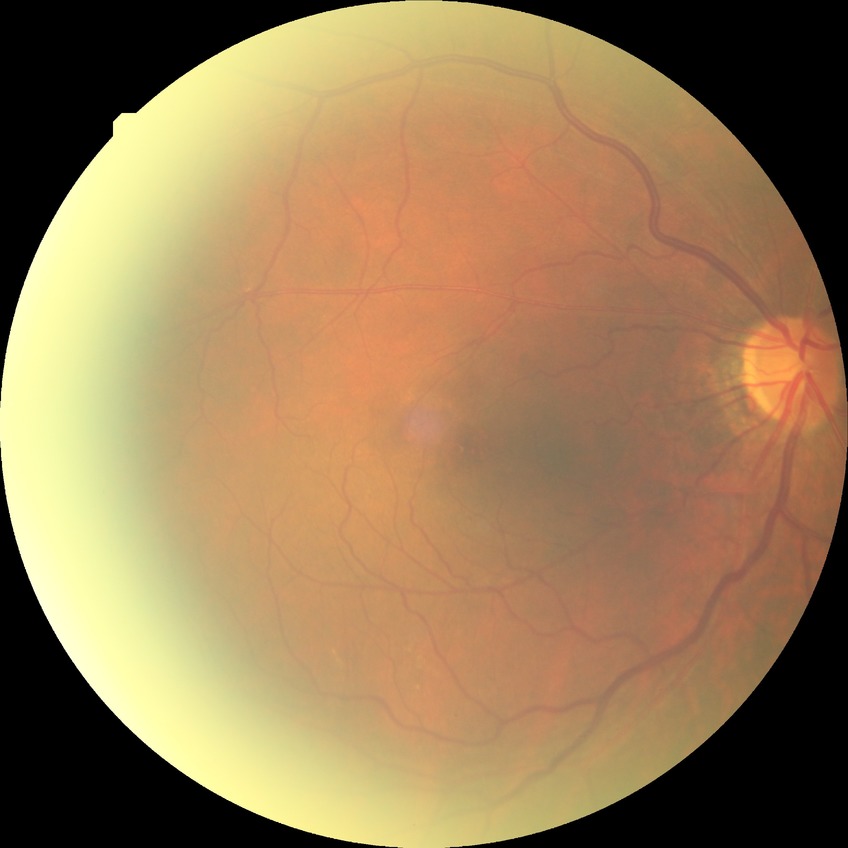 Davis grading is no diabetic retinopathy.